Graded on the modified Davis scale
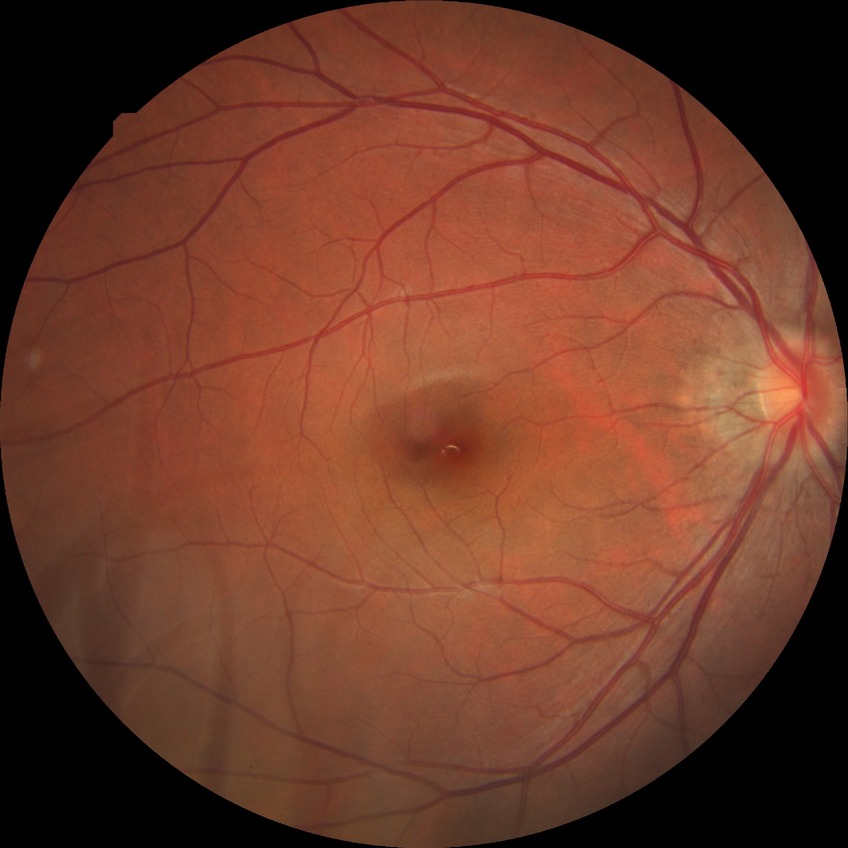

Diabetic retinopathy (DR) is no diabetic retinopathy (NDR).